Centered on the optic disc; 30° field of view; 2212x1661px:
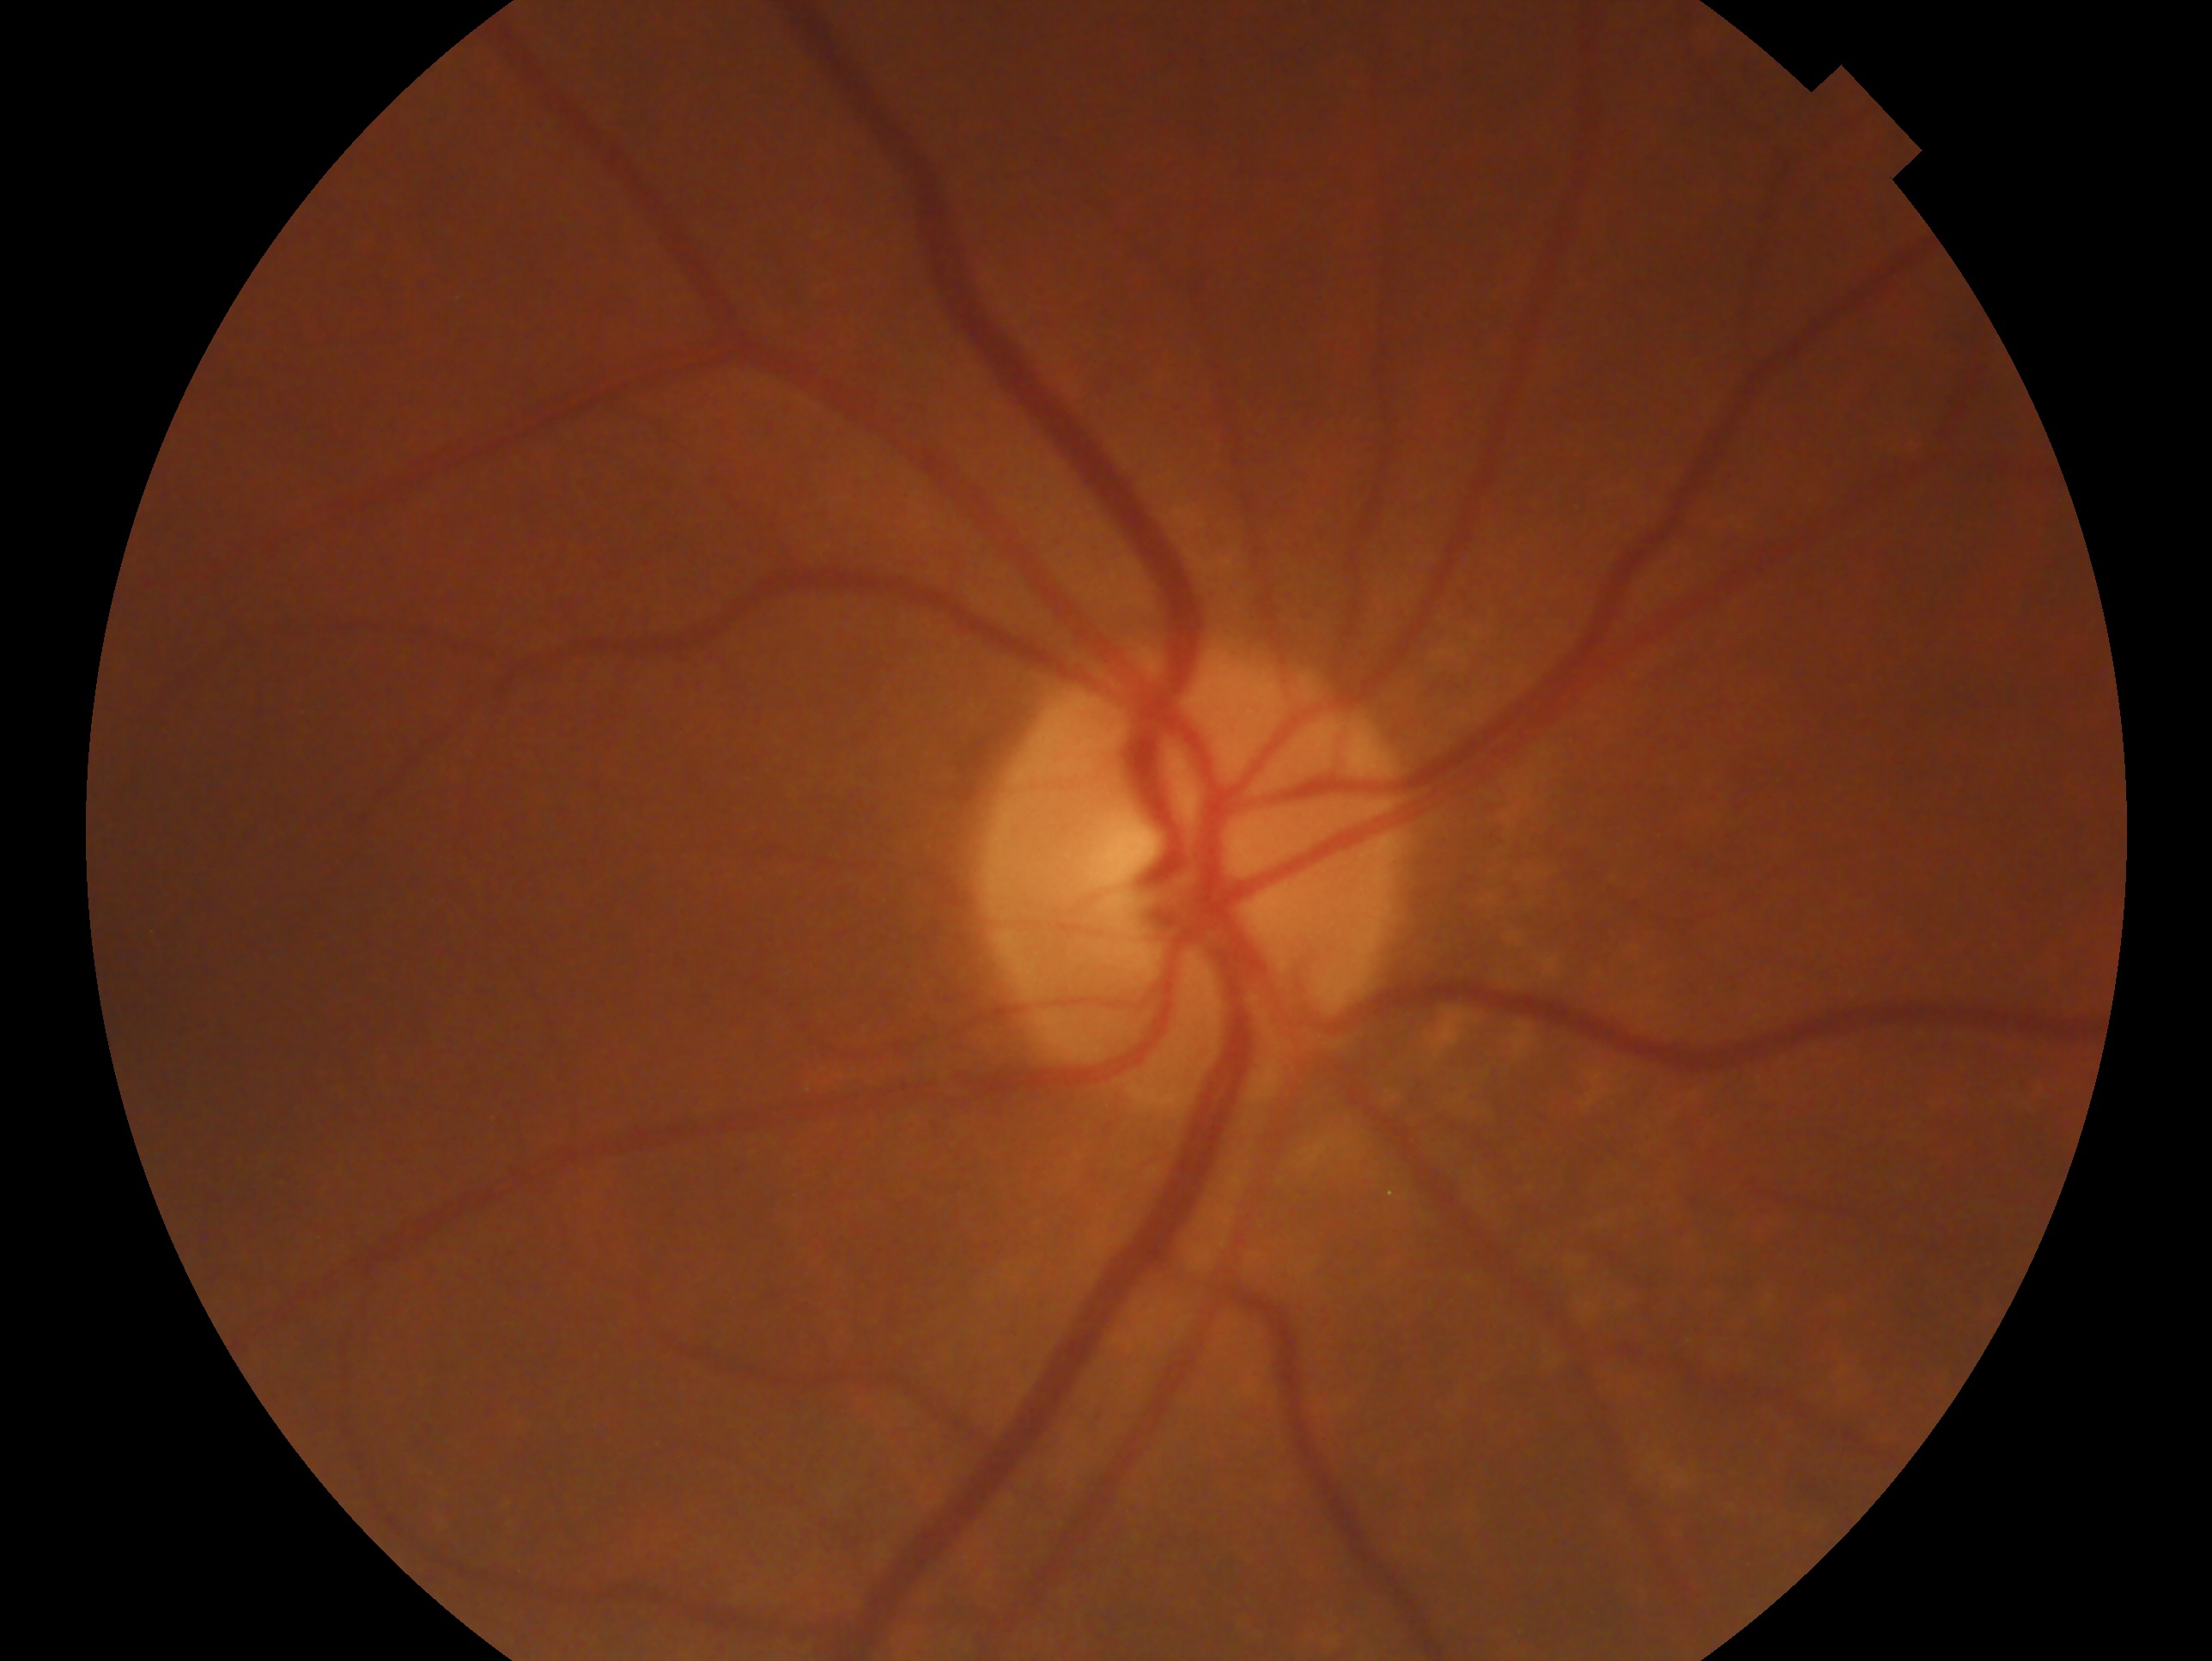
This is the right eye.
Glaucoma status: no signs of glaucoma — no clinical evidence of glaucoma in this eye.